Image size 640x480 · wide-field fundus photograph from neonatal ROP screening: 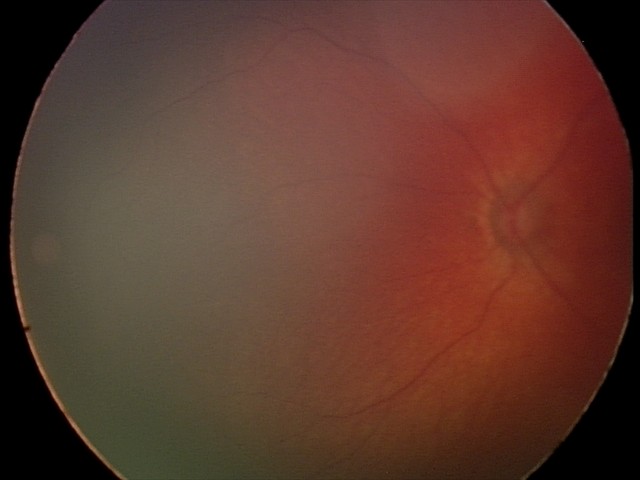

From an examination with diagnosis of retinal hemorrhages.